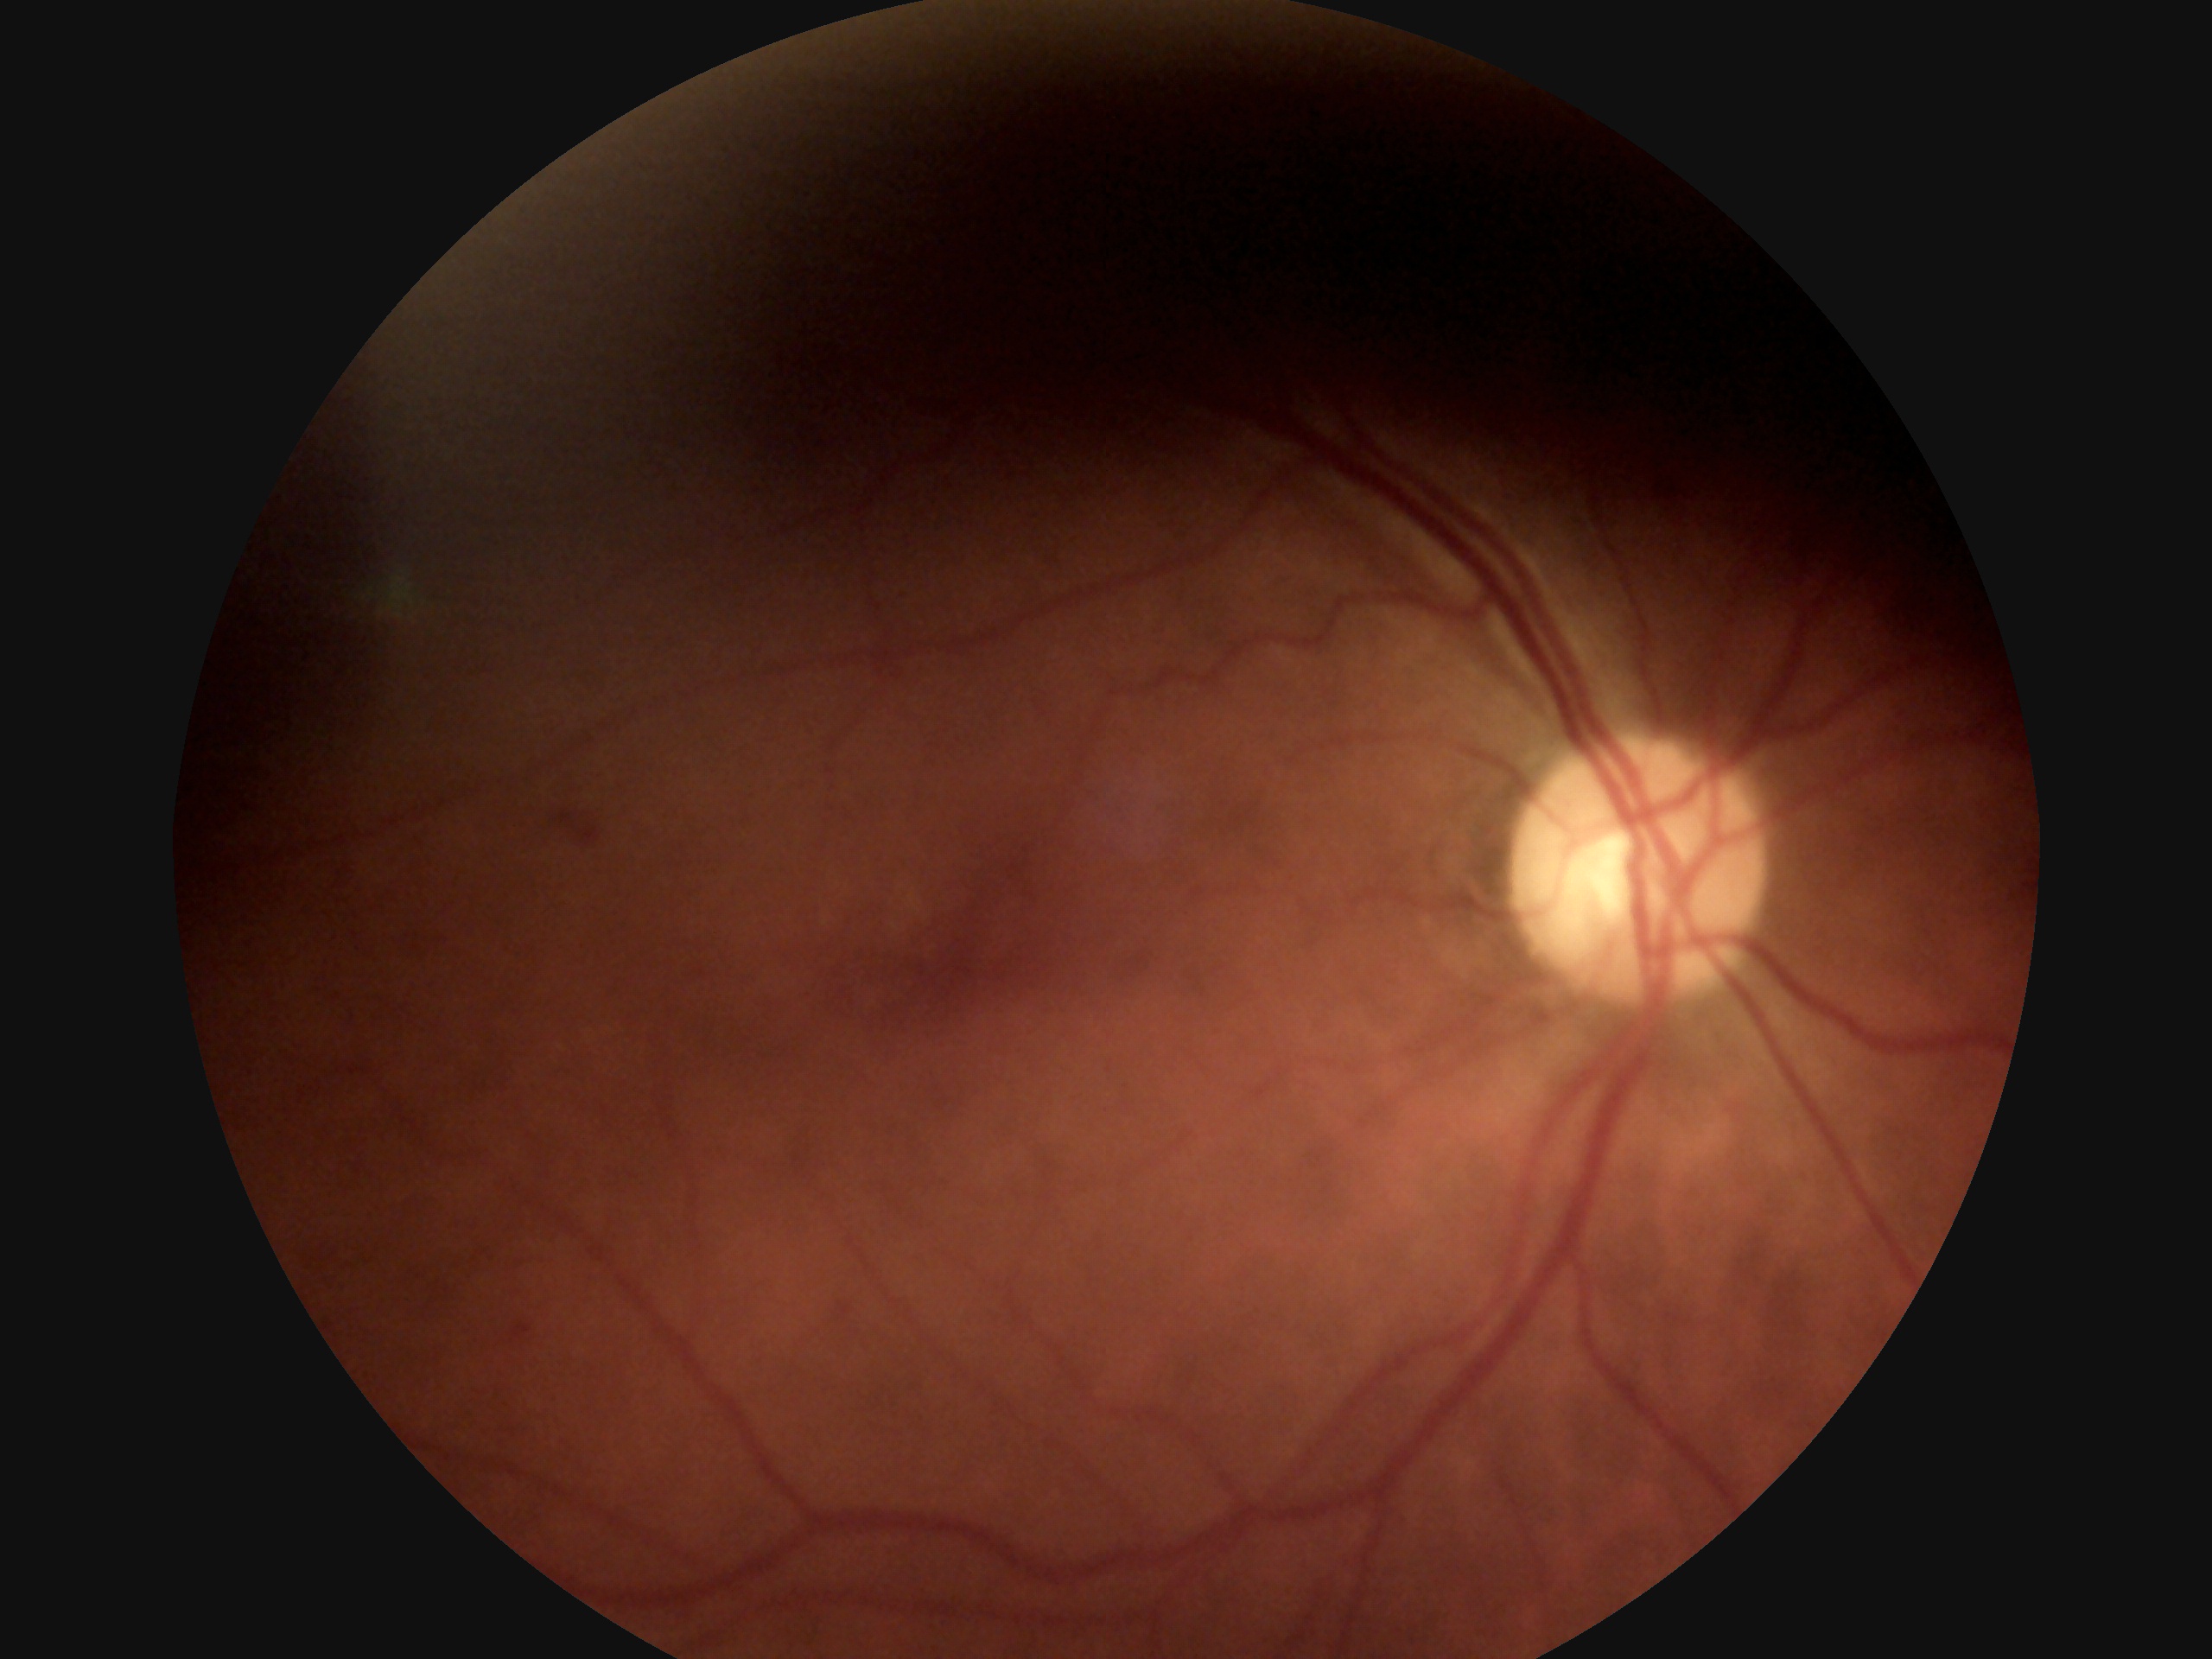 {"dr_grade": "2", "dr_category": "non-proliferative diabetic retinopathy"}